Color fundus image; 1936 by 1296 pixels — 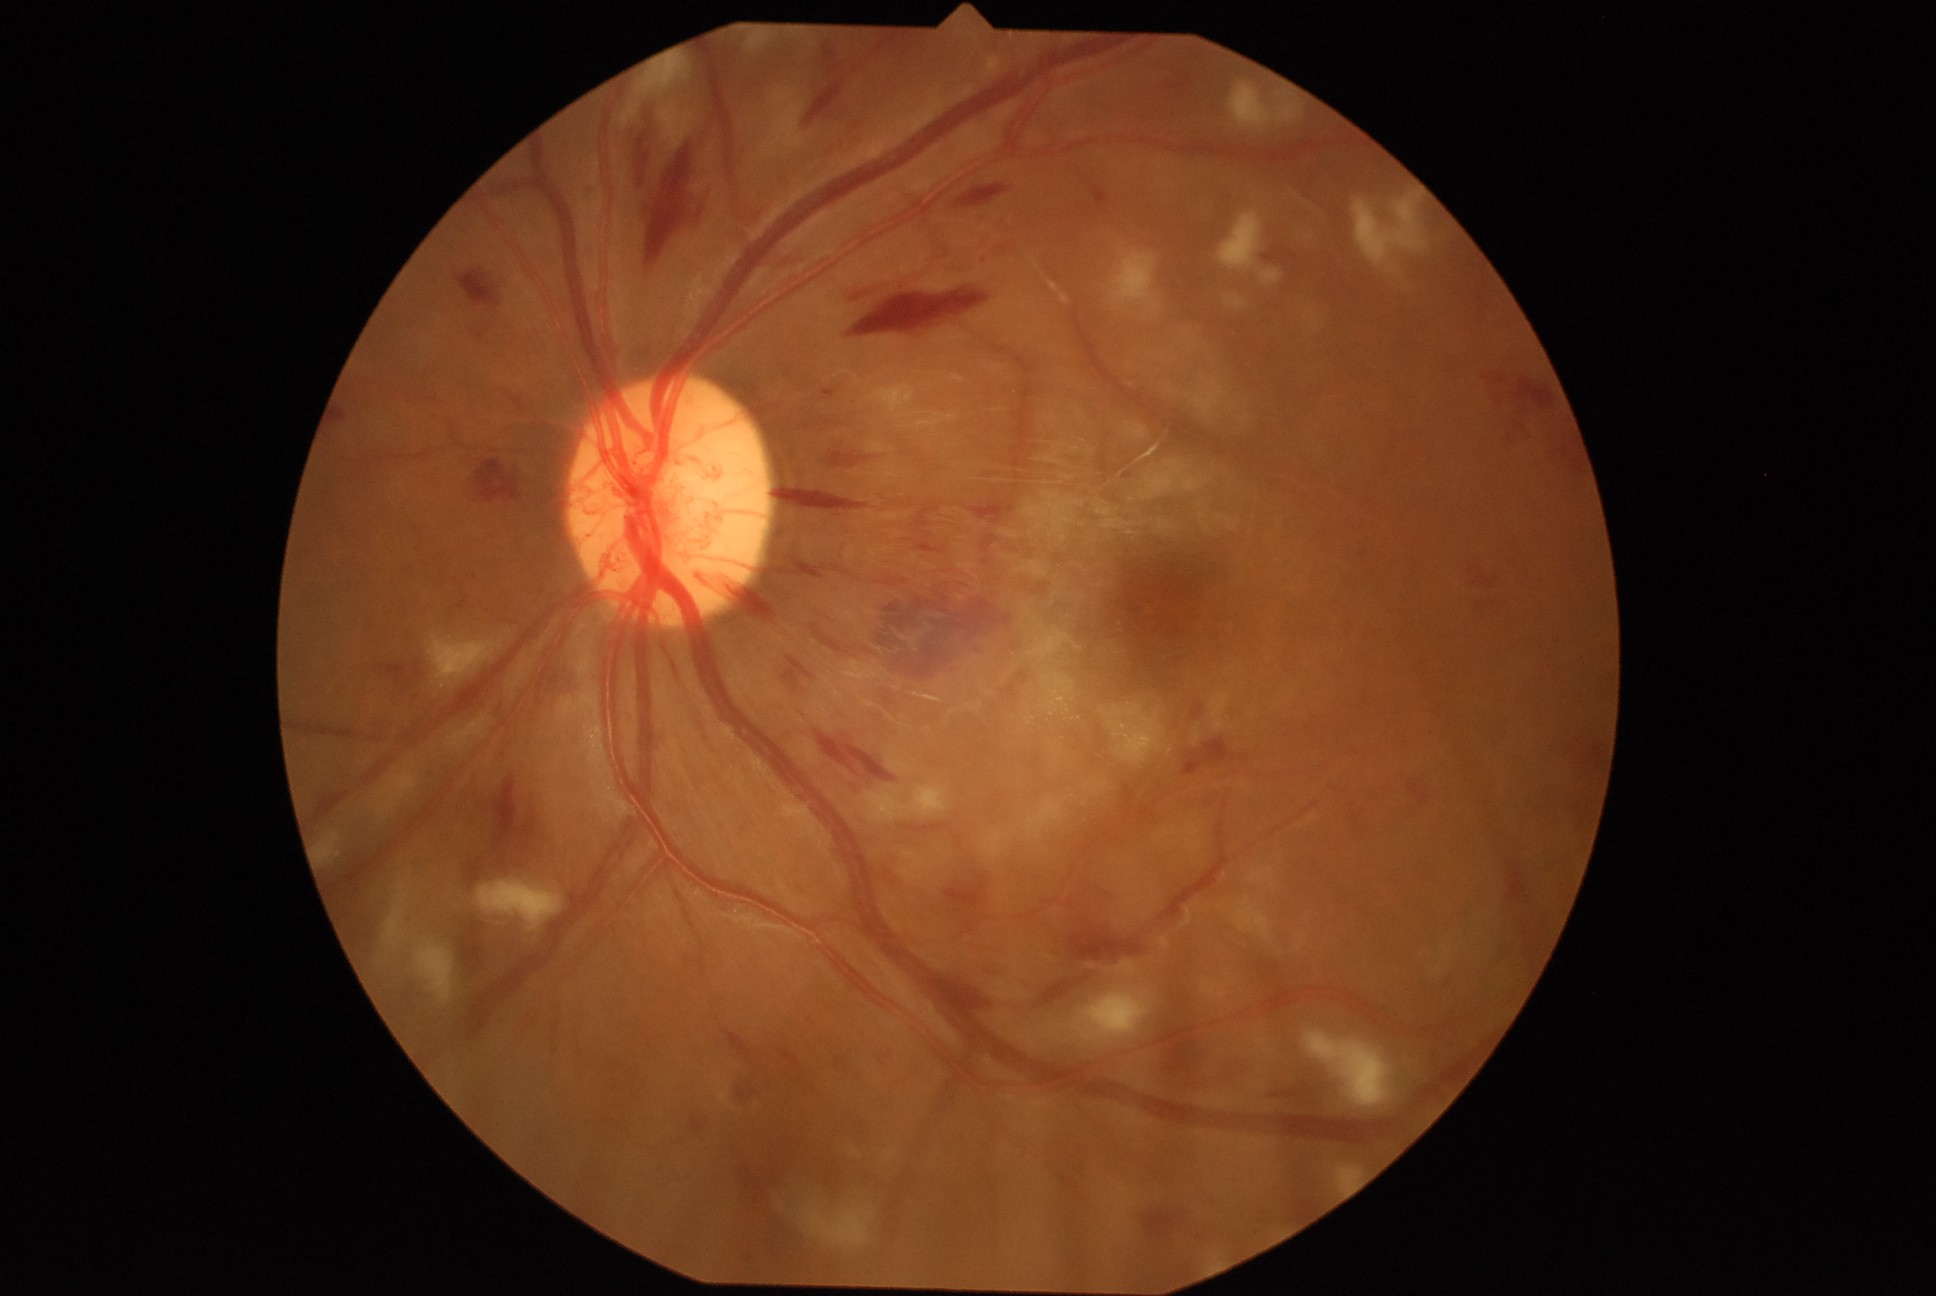
DR: proliferative diabetic retinopathy (grade 4)
A subset of detected lesions:
HEs (more not shown) = left=826, top=451, right=875, bottom=468; left=723, top=1028, right=754, bottom=1059; left=916, top=502, right=938, bottom=527; left=380, top=664, right=408, bottom=684; left=779, top=1049, right=801, bottom=1068; left=742, top=1167, right=753, bottom=1183; left=1517, top=379, right=1556, bottom=410; left=423, top=397, right=437, bottom=402; left=811, top=626, right=857, bottom=658; left=847, top=782, right=863, bottom=798; left=1352, top=816, right=1360, bottom=829; left=1273, top=1088, right=1301, bottom=1099; left=819, top=733, right=896, bottom=791; left=765, top=489, right=861, bottom=513; left=329, top=407, right=347, bottom=427; left=457, top=268, right=500, bottom=308
HEs (small, approximate centers) near [1163,1234]